240x240px
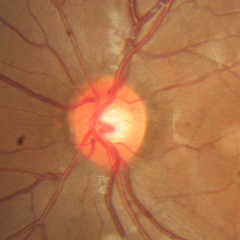

Glaucoma stage = no signs of glaucoma.